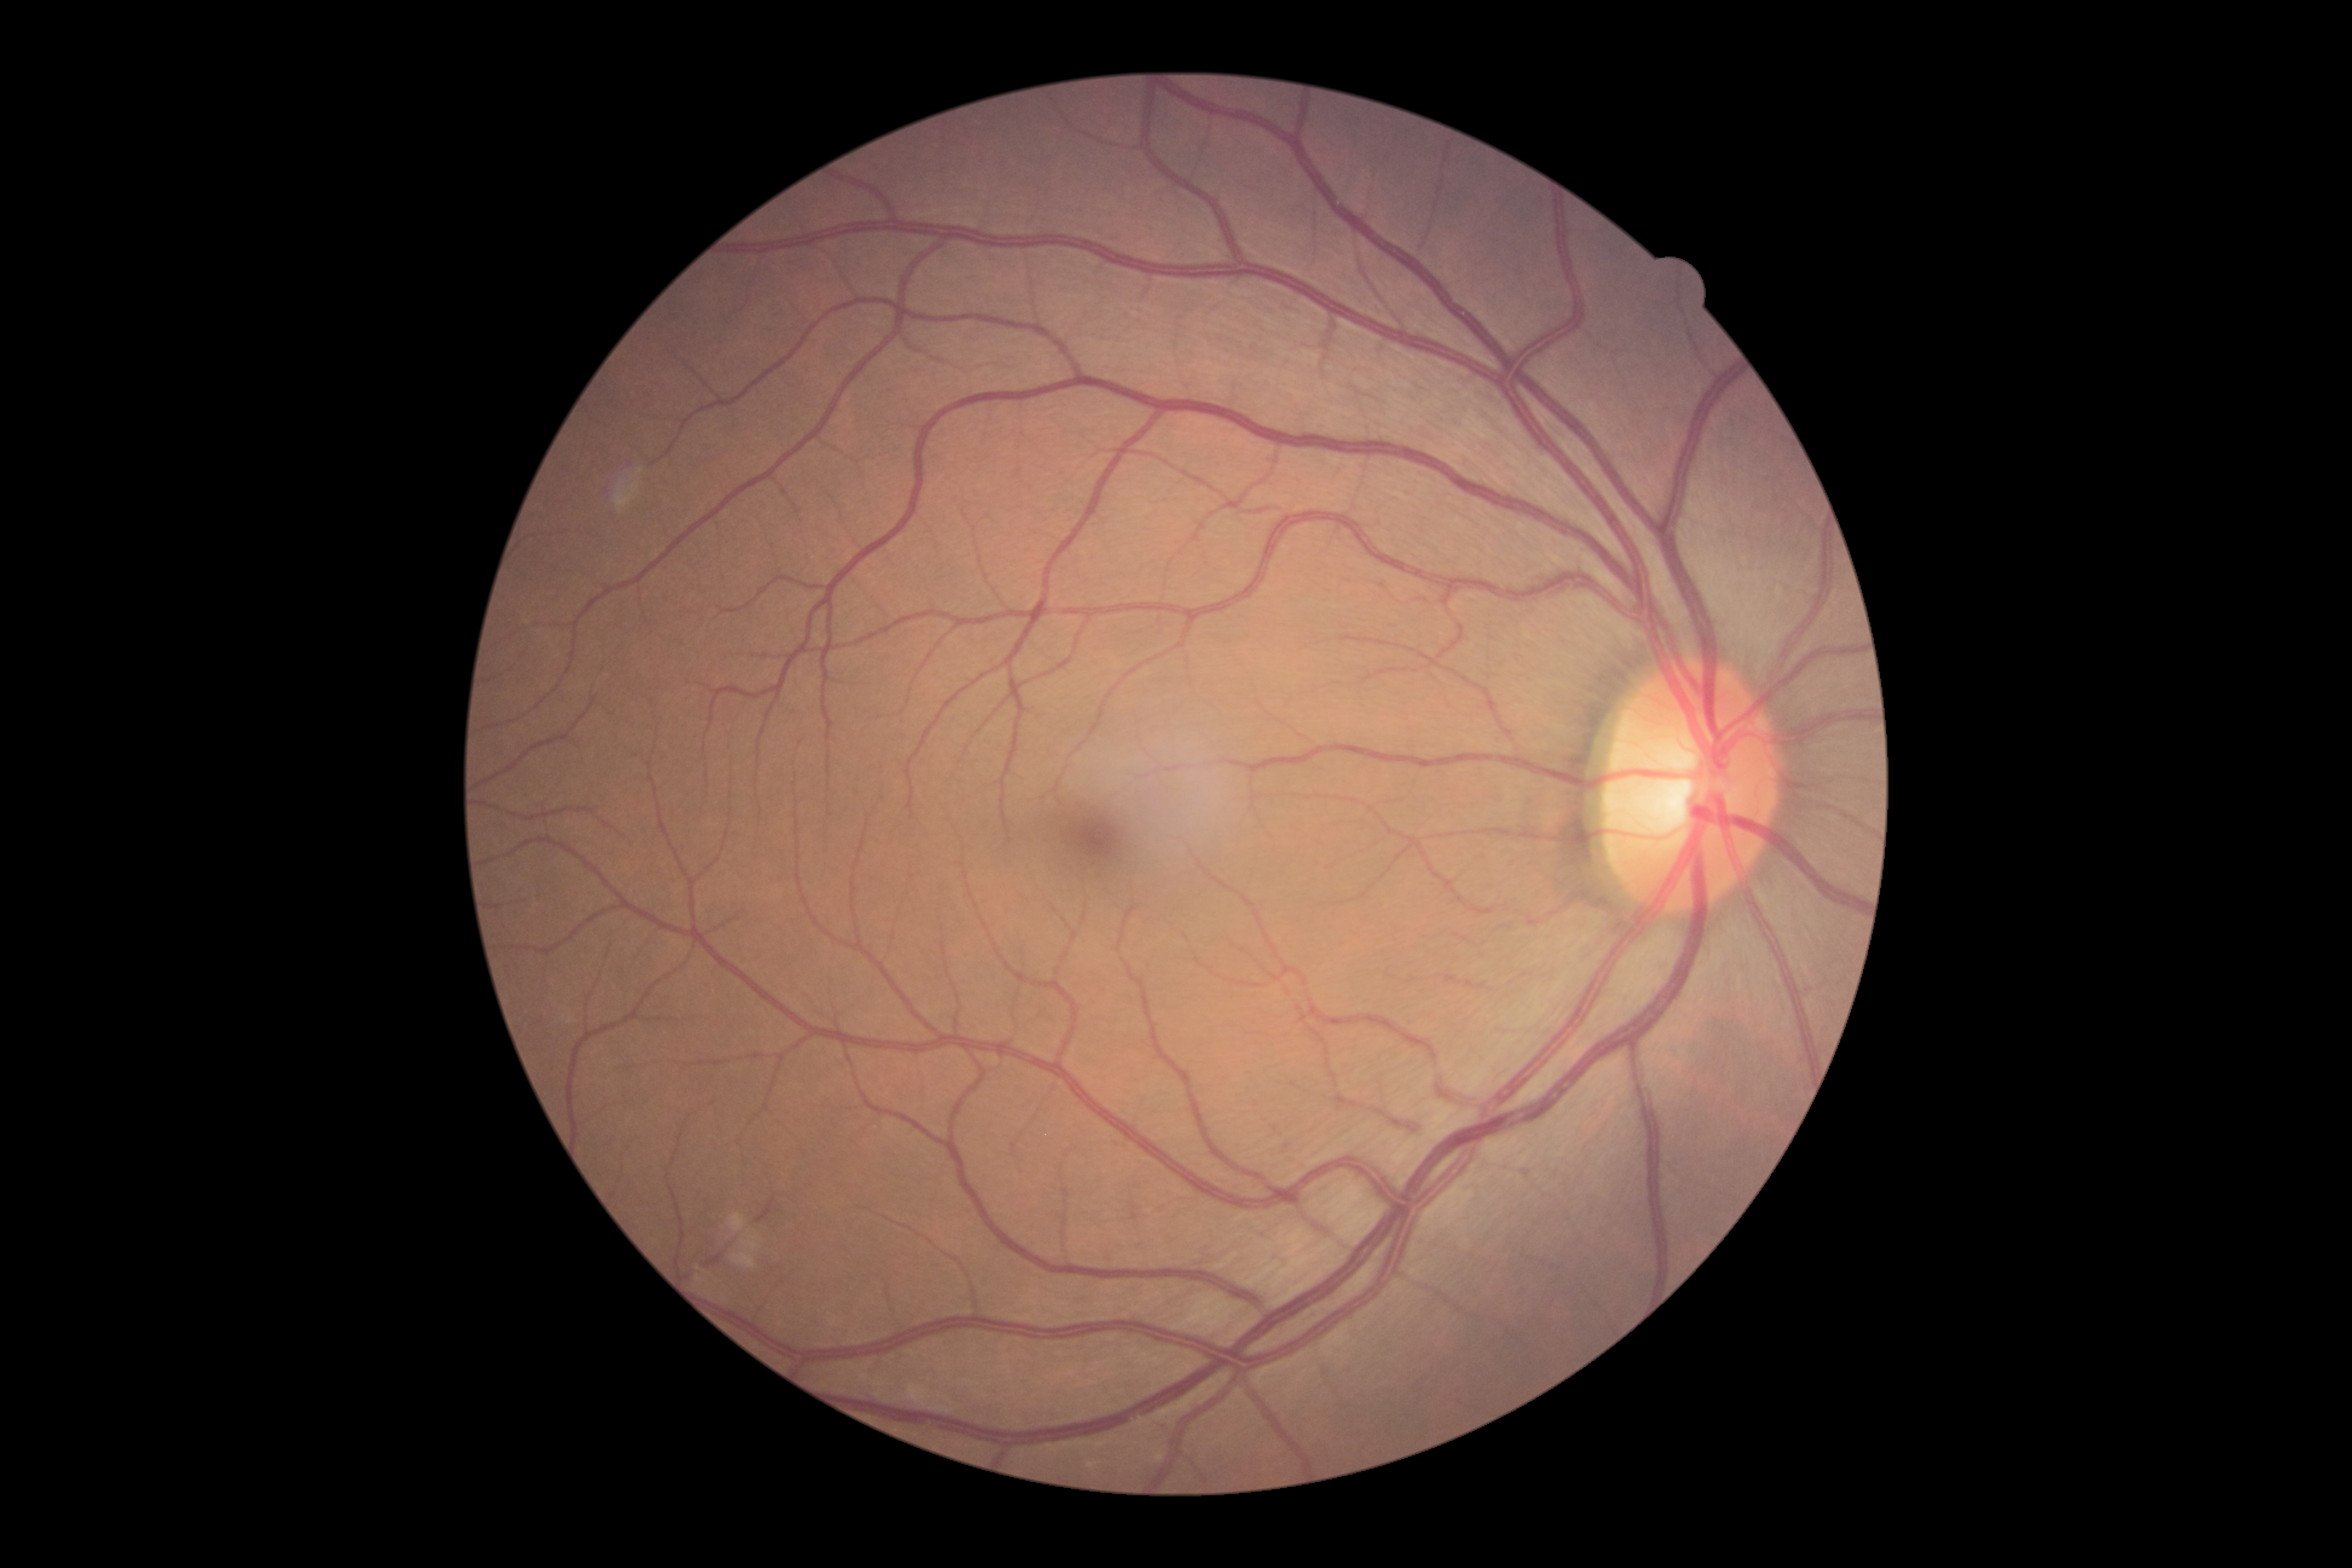 Diabetic retinopathy severity: no apparent diabetic retinopathy (grade 0).